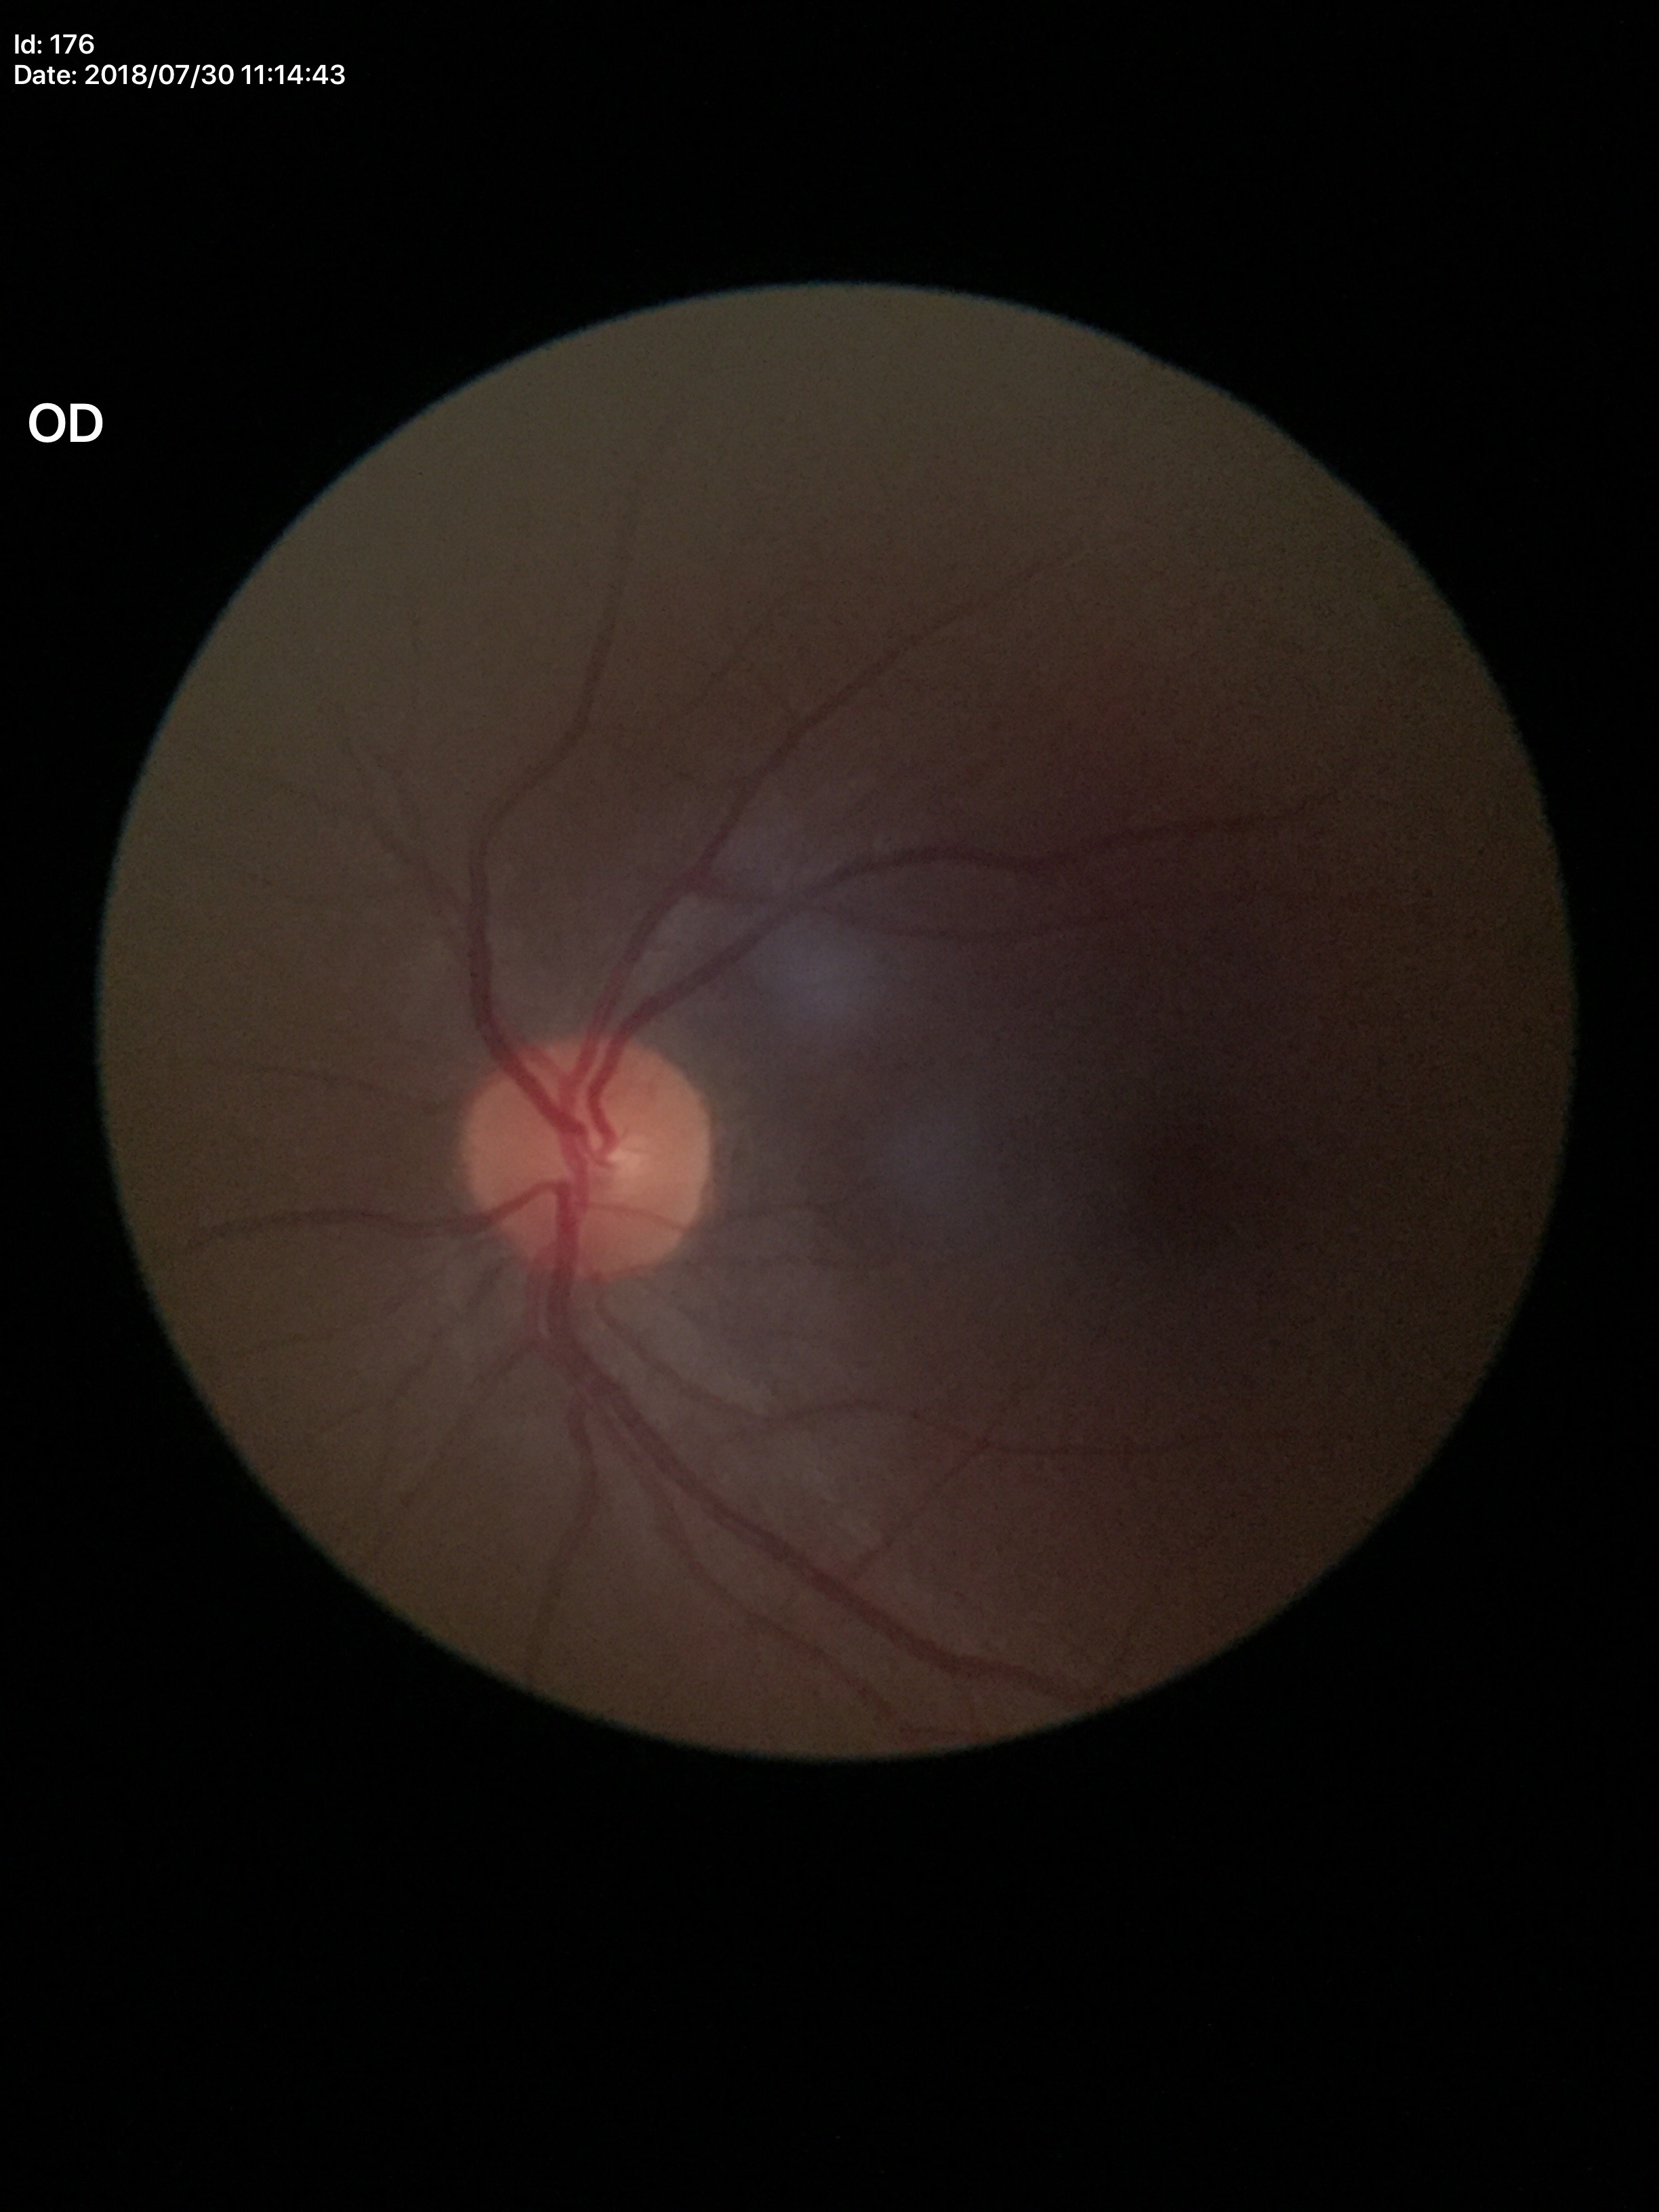

Glaucoma evaluation: negative.
Horizontal cup-to-disc ratio: 0.42.
Vertical C/D ratio is 0.41.